45° FOV; 848 by 848 pixels.
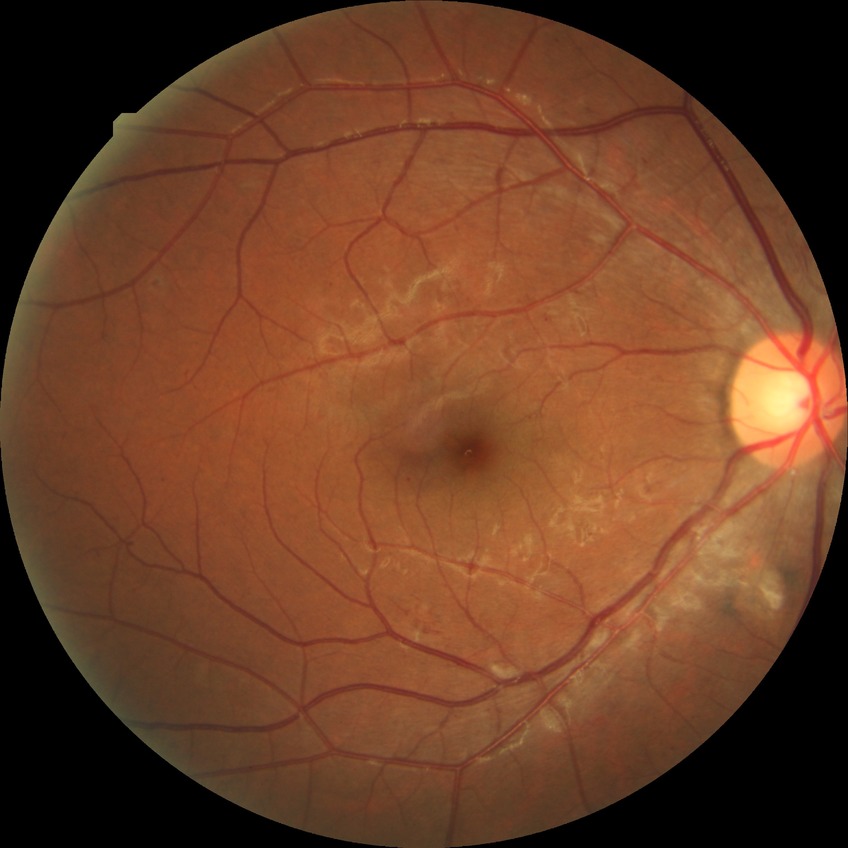

Findings:
• DR class — non-proliferative diabetic retinopathy
• diabetic retinopathy (DR) — pre-proliferative diabetic retinopathy (PPDR)